Davis DR grading.
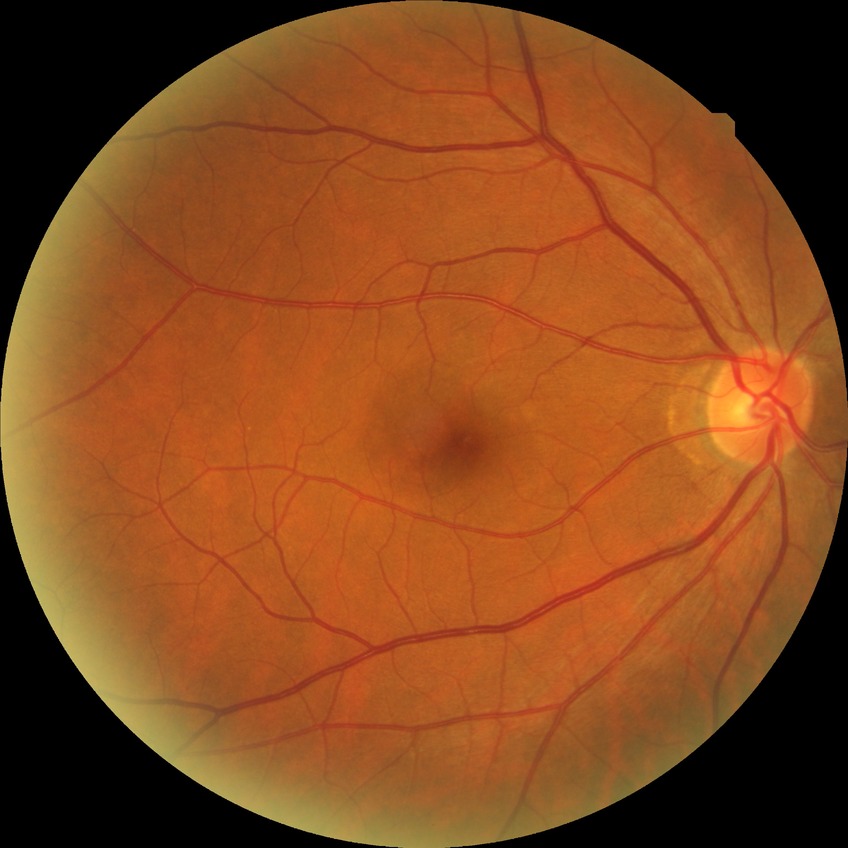
Davis grade: NDR.